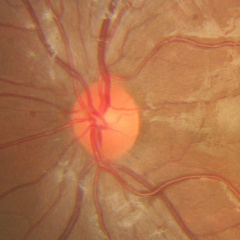
Q: What stage of glaucoma is present?
A: No signs of glaucoma.